1932 by 1916 pixels. 45° field of view
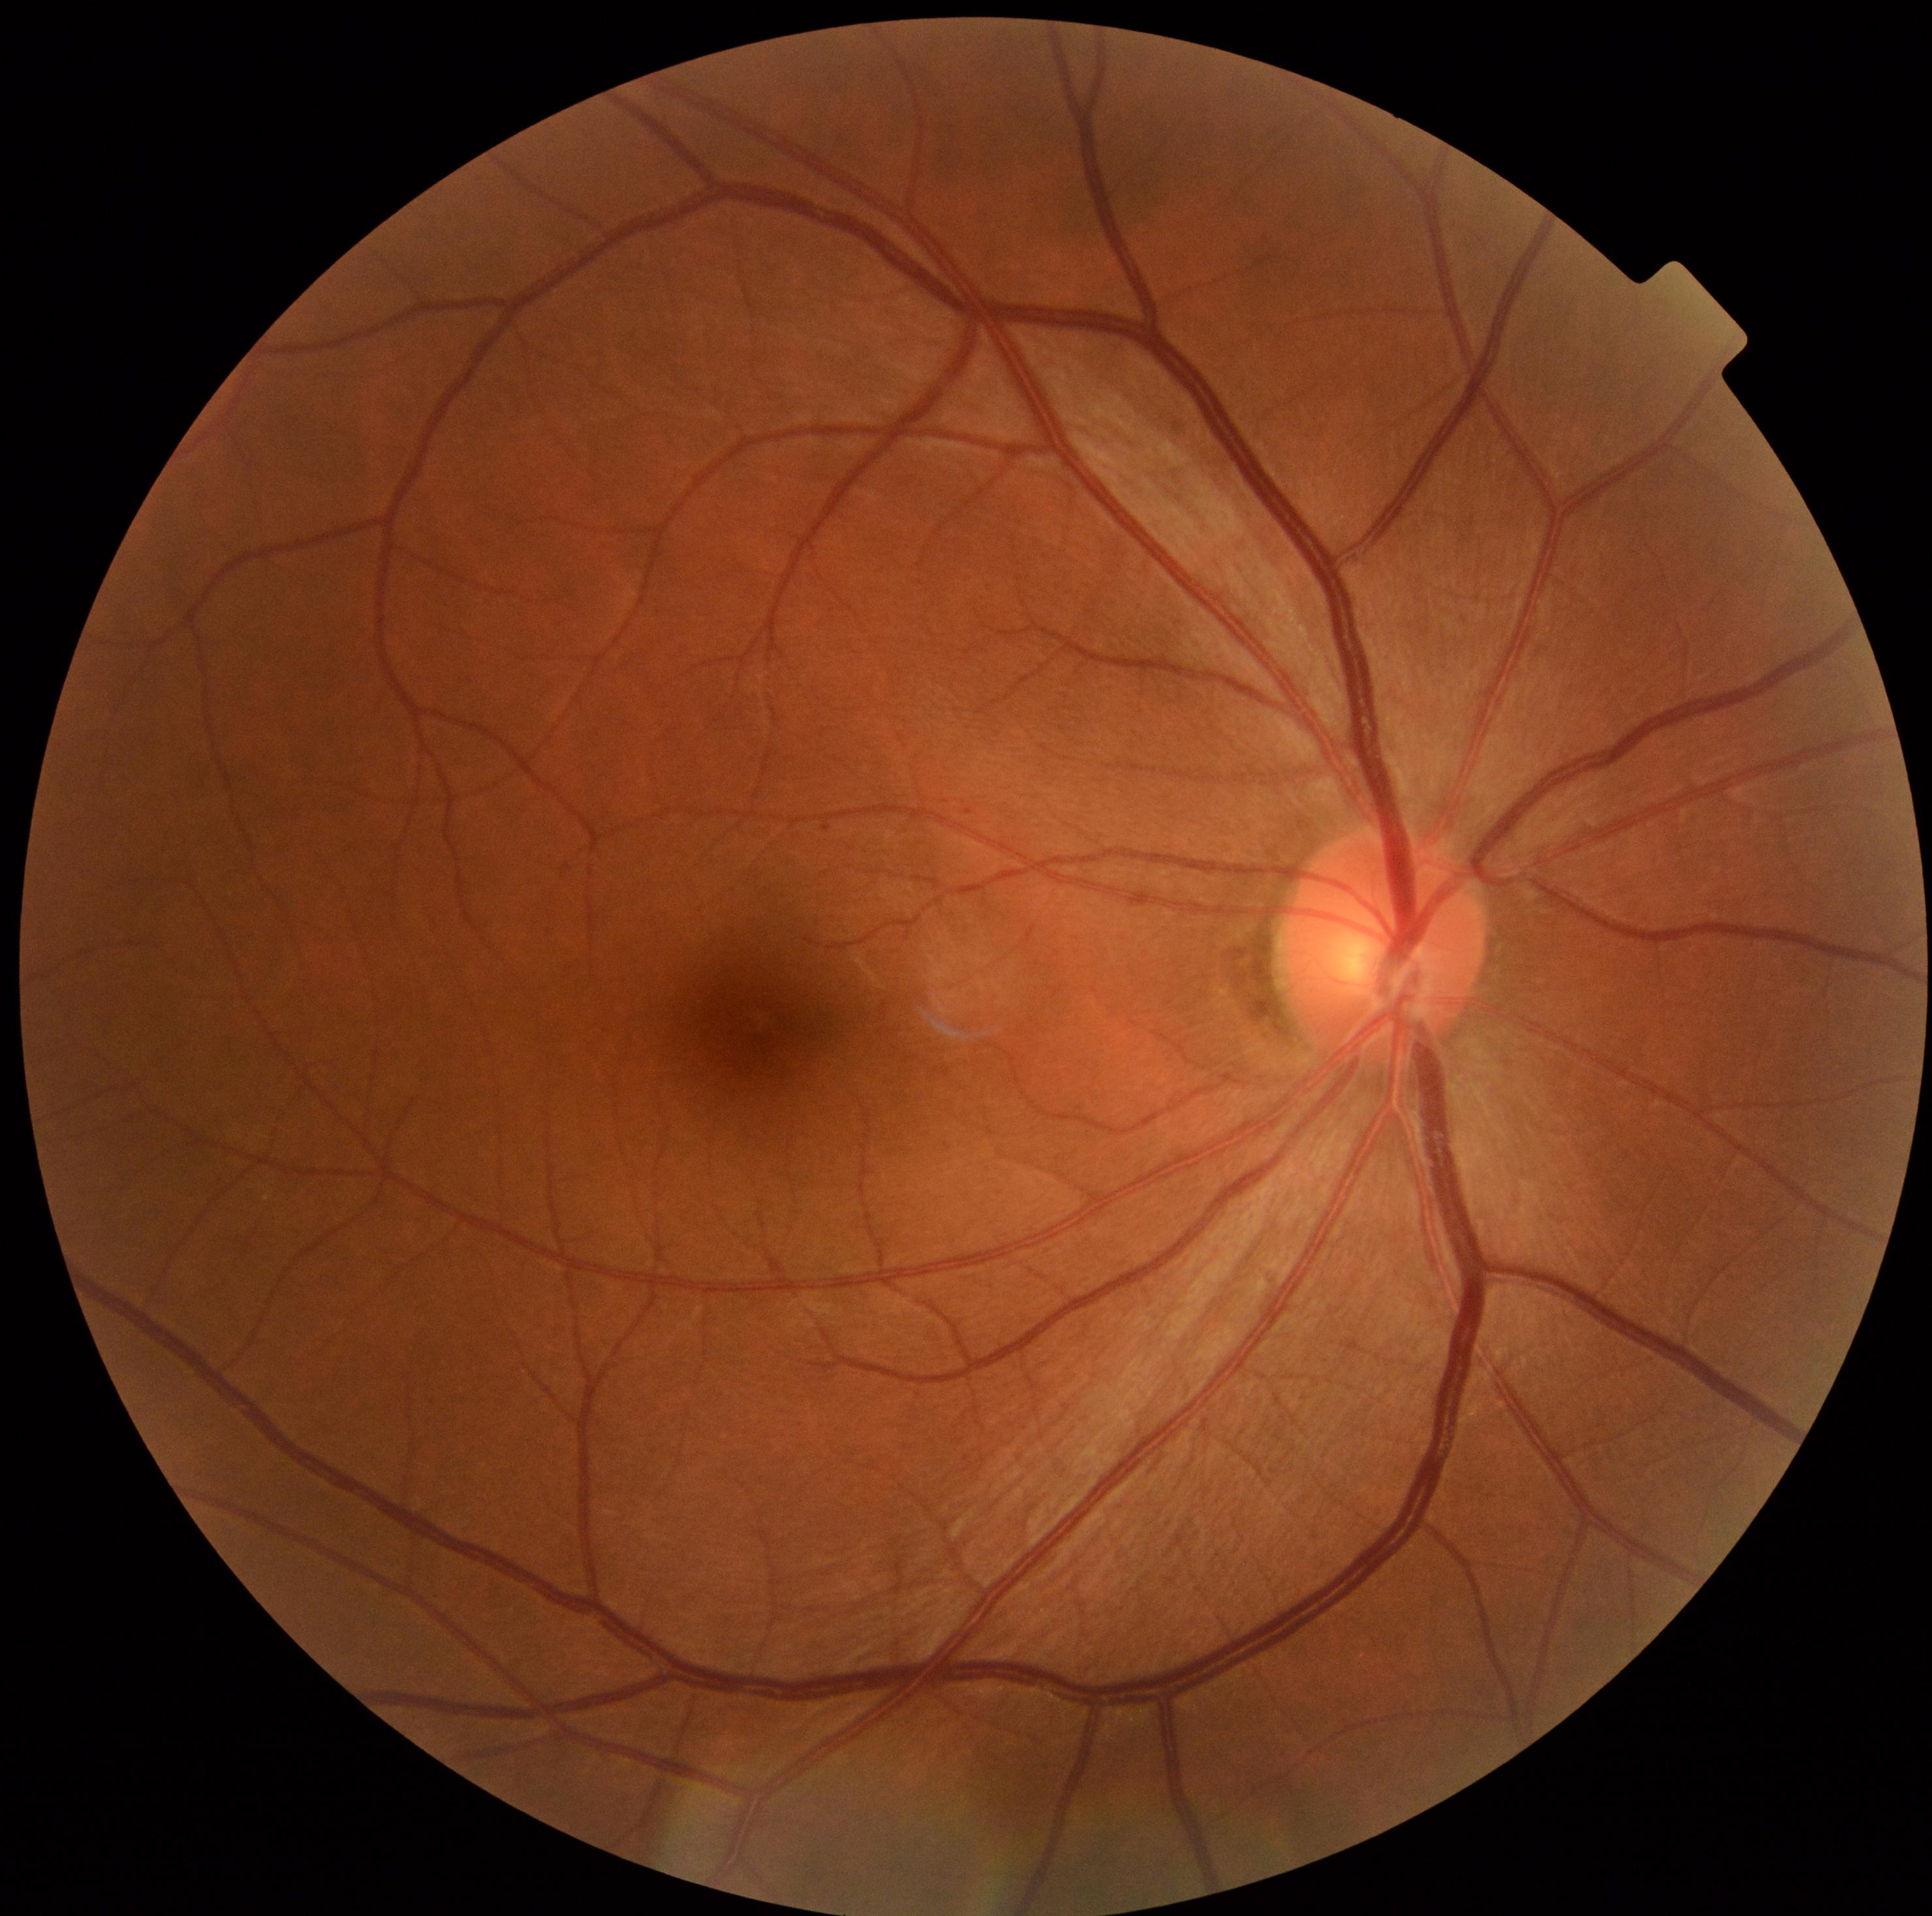
DR class = non-proliferative diabetic retinopathy; diabetic retinopathy (DR) = grade 1 (mild NPDR).